2352x1568; fundus photo; 45-degree field of view
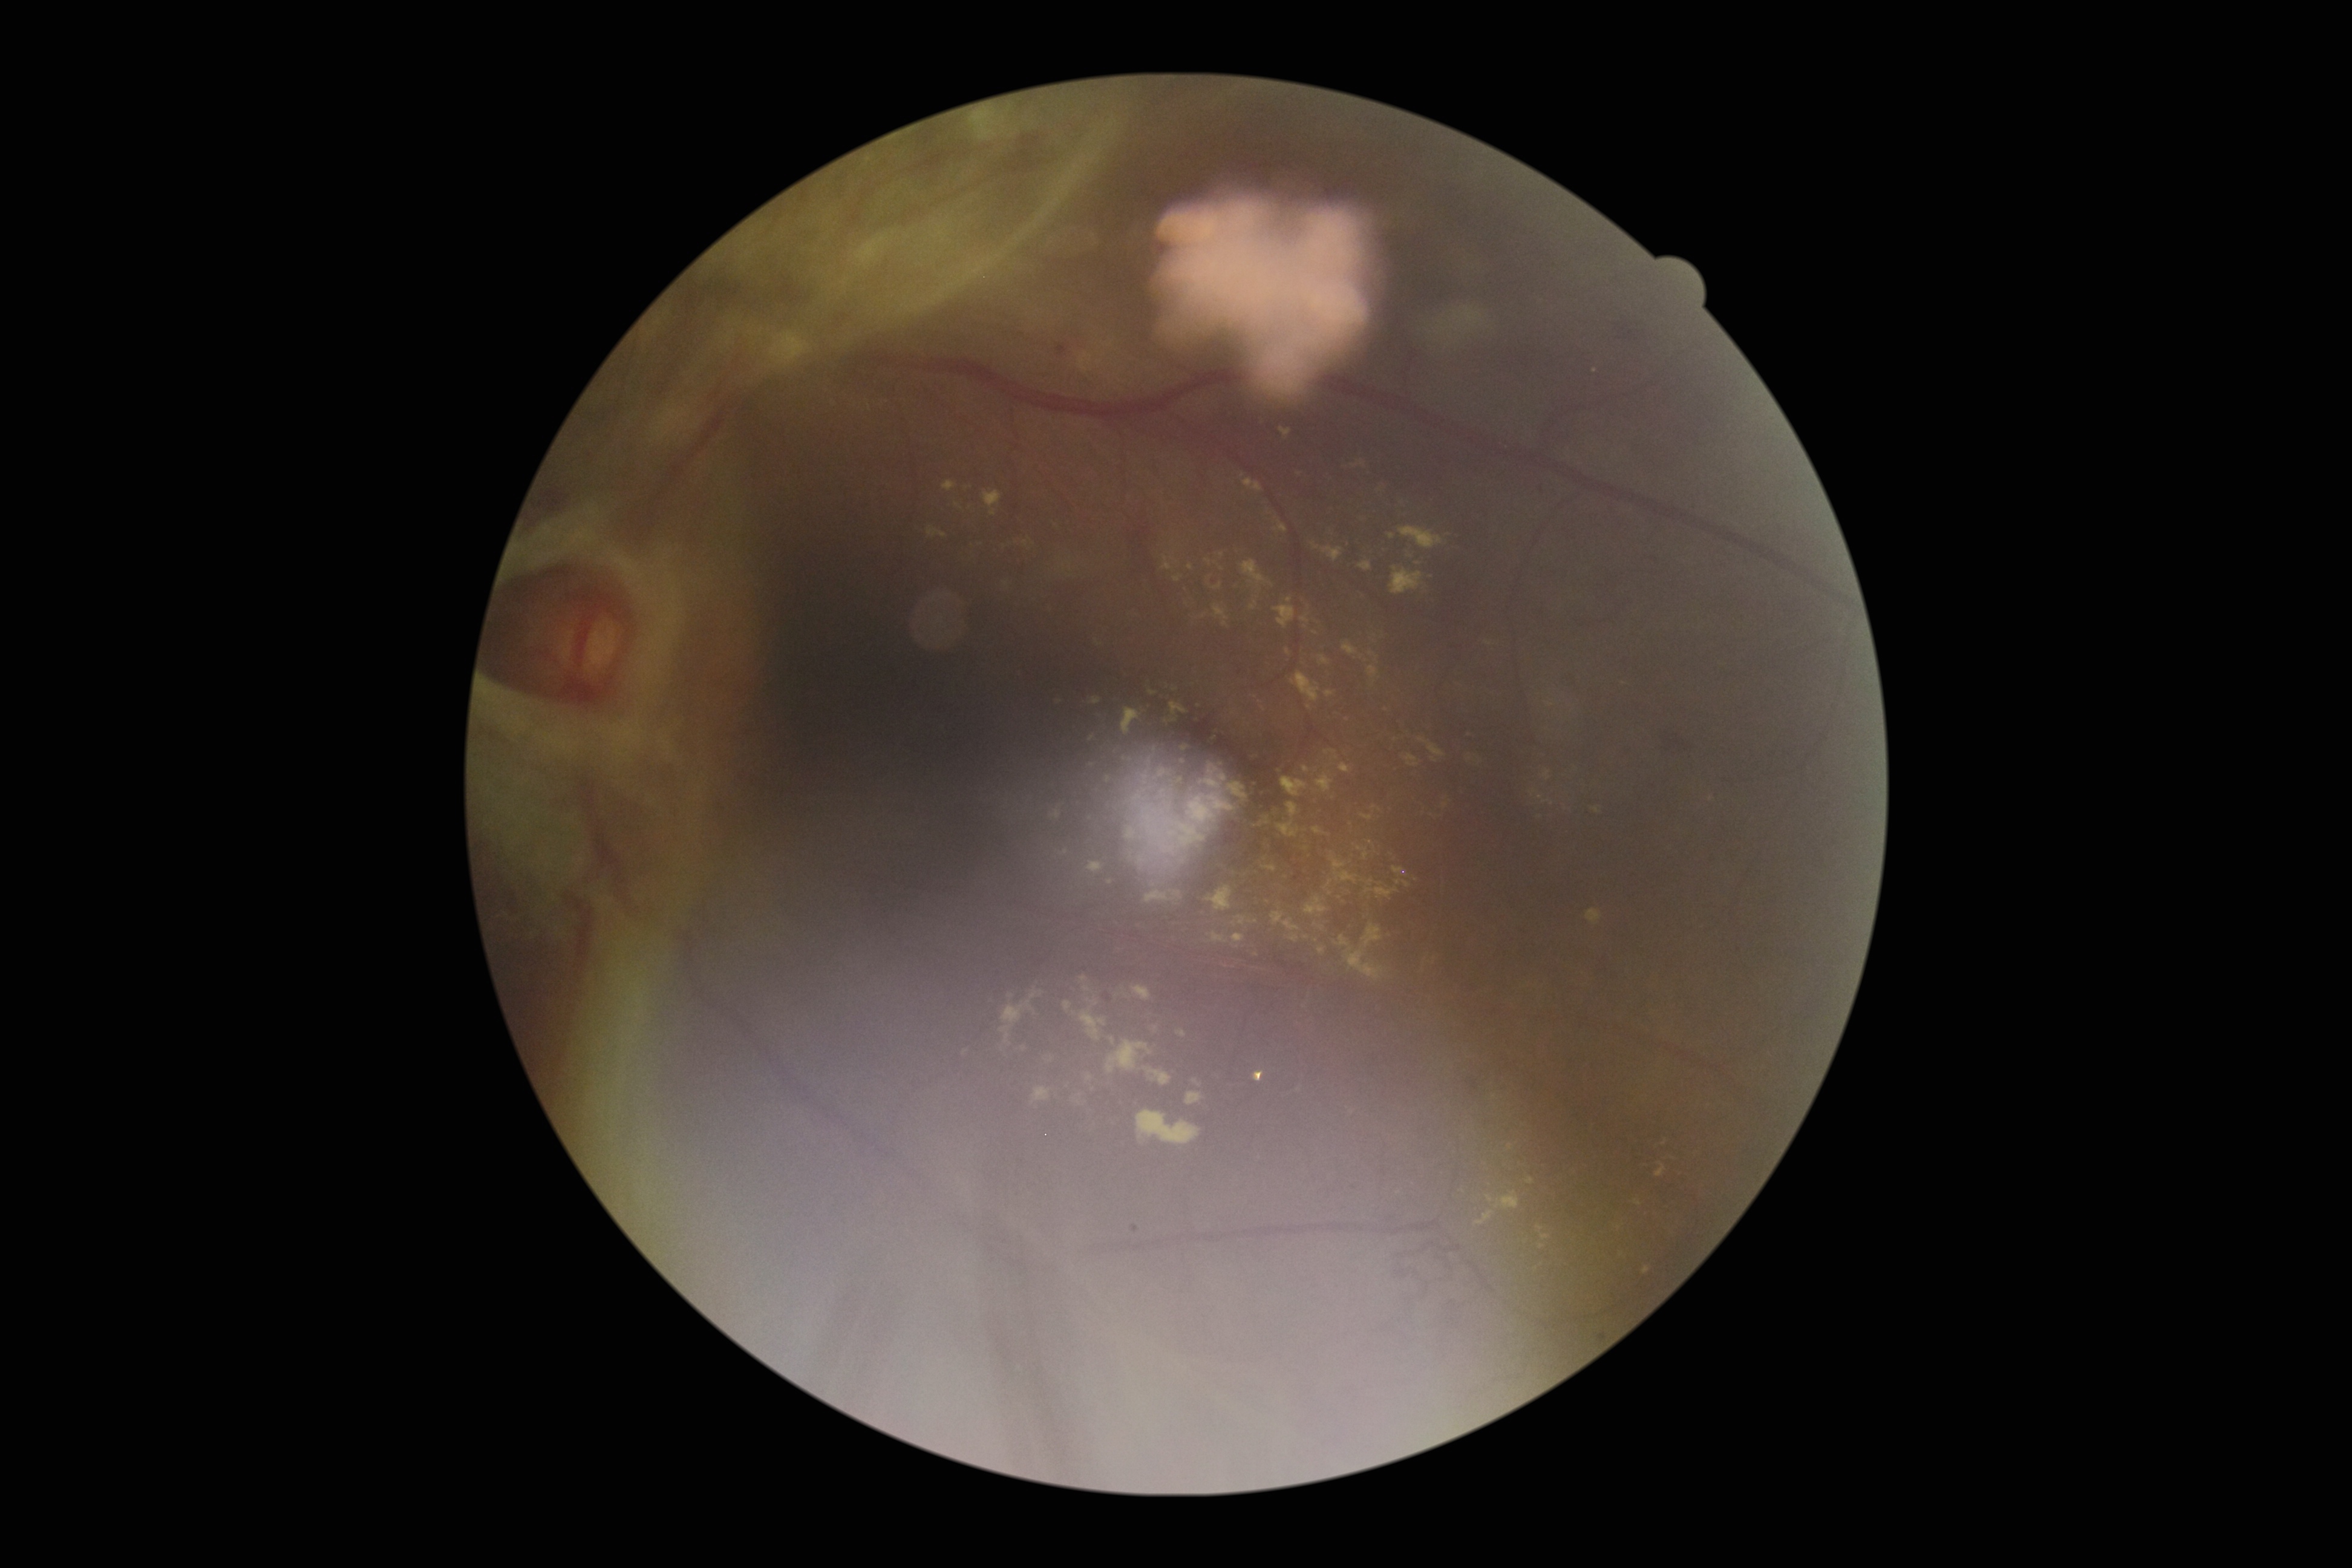

Diabetic retinopathy (DR): grade 4
Lesions identified (partial list):
* hard exudates (EXs) (more not shown): x1=1204 y1=881 x2=1235 y2=914; x1=1273 y1=520 x2=1288 y2=534; x1=1174 y1=1029 x2=1189 y2=1036; x1=1351 y1=875 x2=1363 y2=887; x1=1486 y1=1196 x2=1494 y2=1203; x1=1031 y1=1088 x2=1051 y2=1106; x1=1311 y1=543 x2=1344 y2=563; x1=1402 y1=756 x2=1420 y2=773; x1=1263 y1=856 x2=1282 y2=869; x1=1542 y1=799 x2=1554 y2=806; x1=1017 y1=1045 x2=1028 y2=1056; x1=1096 y1=1039 x2=1177 y2=1091; x1=1307 y1=895 x2=1331 y2=912; x1=1422 y1=798 x2=1445 y2=821; x1=1236 y1=932 x2=1248 y2=947
* Small EXs near [x=1488, y=644]; [x=1540, y=797]; [x=1534, y=793]